1474 x 1482 pixels. FOV: 45 degrees. Fundus photo — 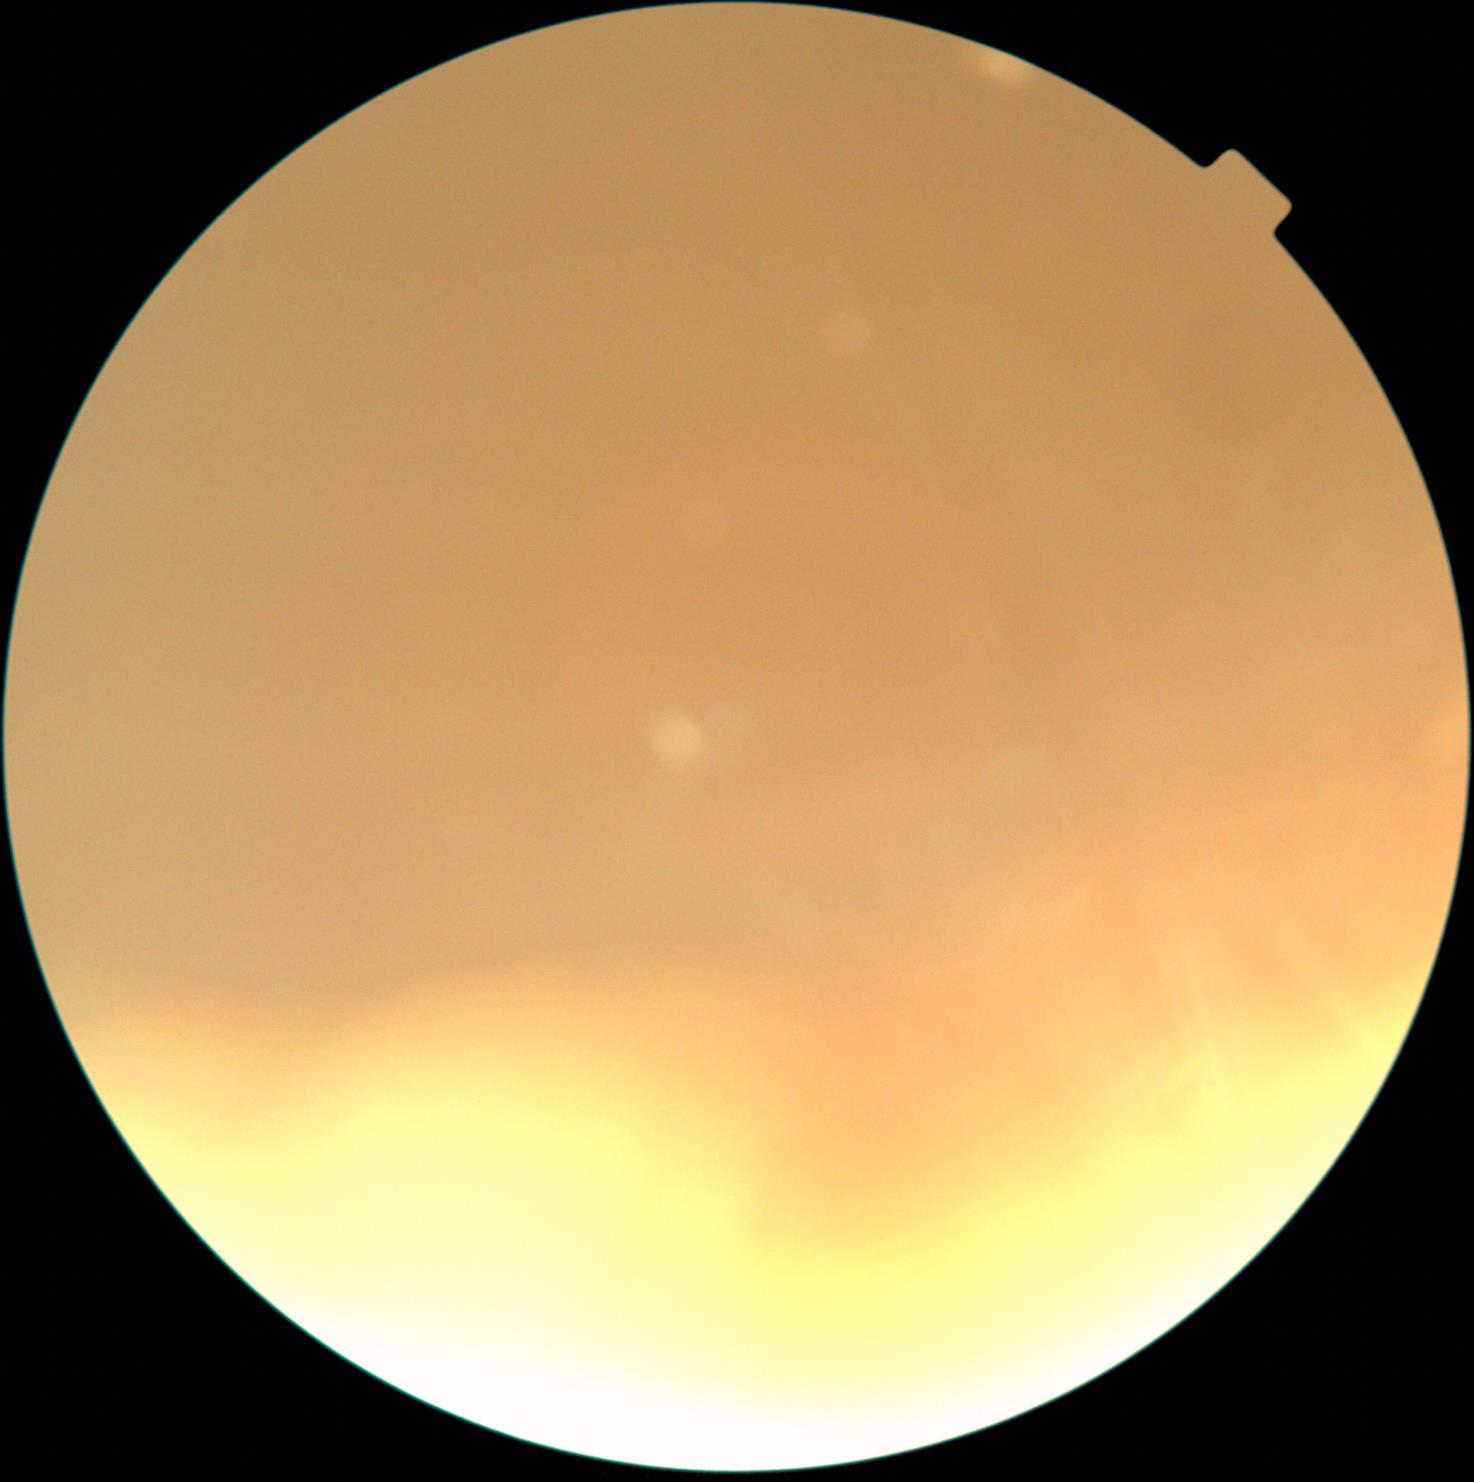
{"quality": "insufficient for DR assessment", "dr_grade": "ungradable due to poor image quality"}